Image size 2352x1568:
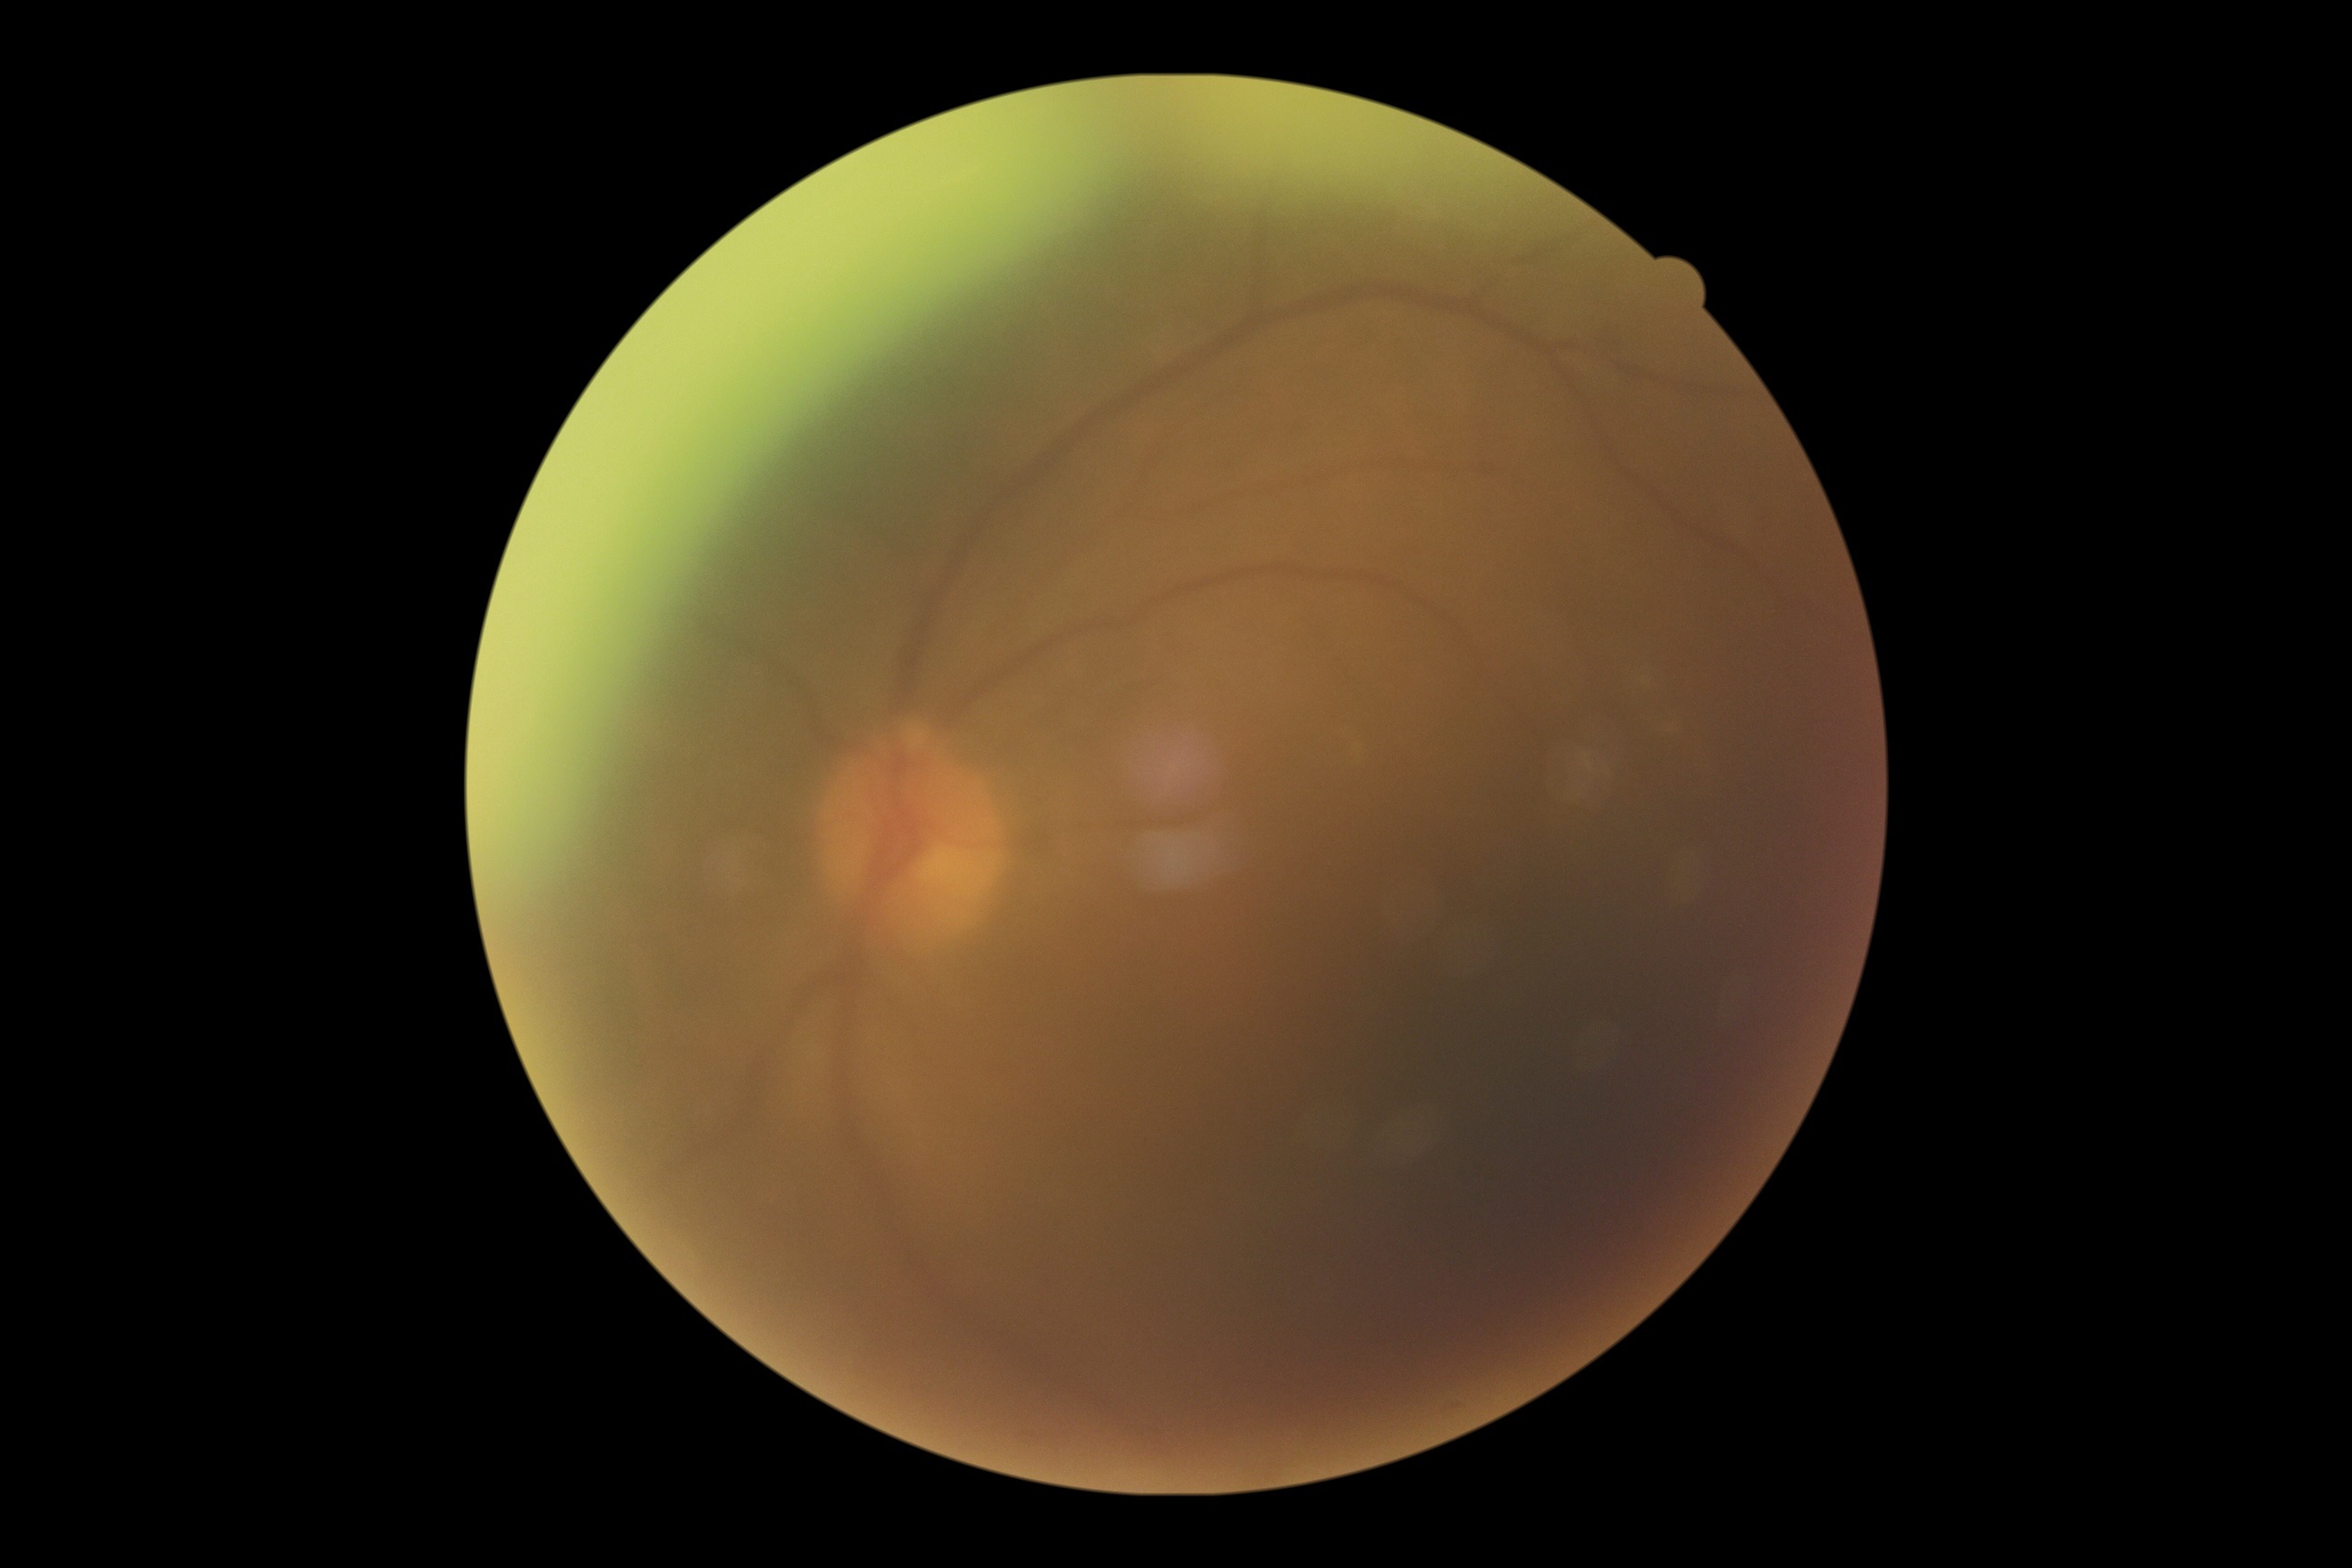 * DR — grade 0
* DR impression — negative for DR